Fundus photo taken with a portable handheld camera, FOV: 60 degrees:
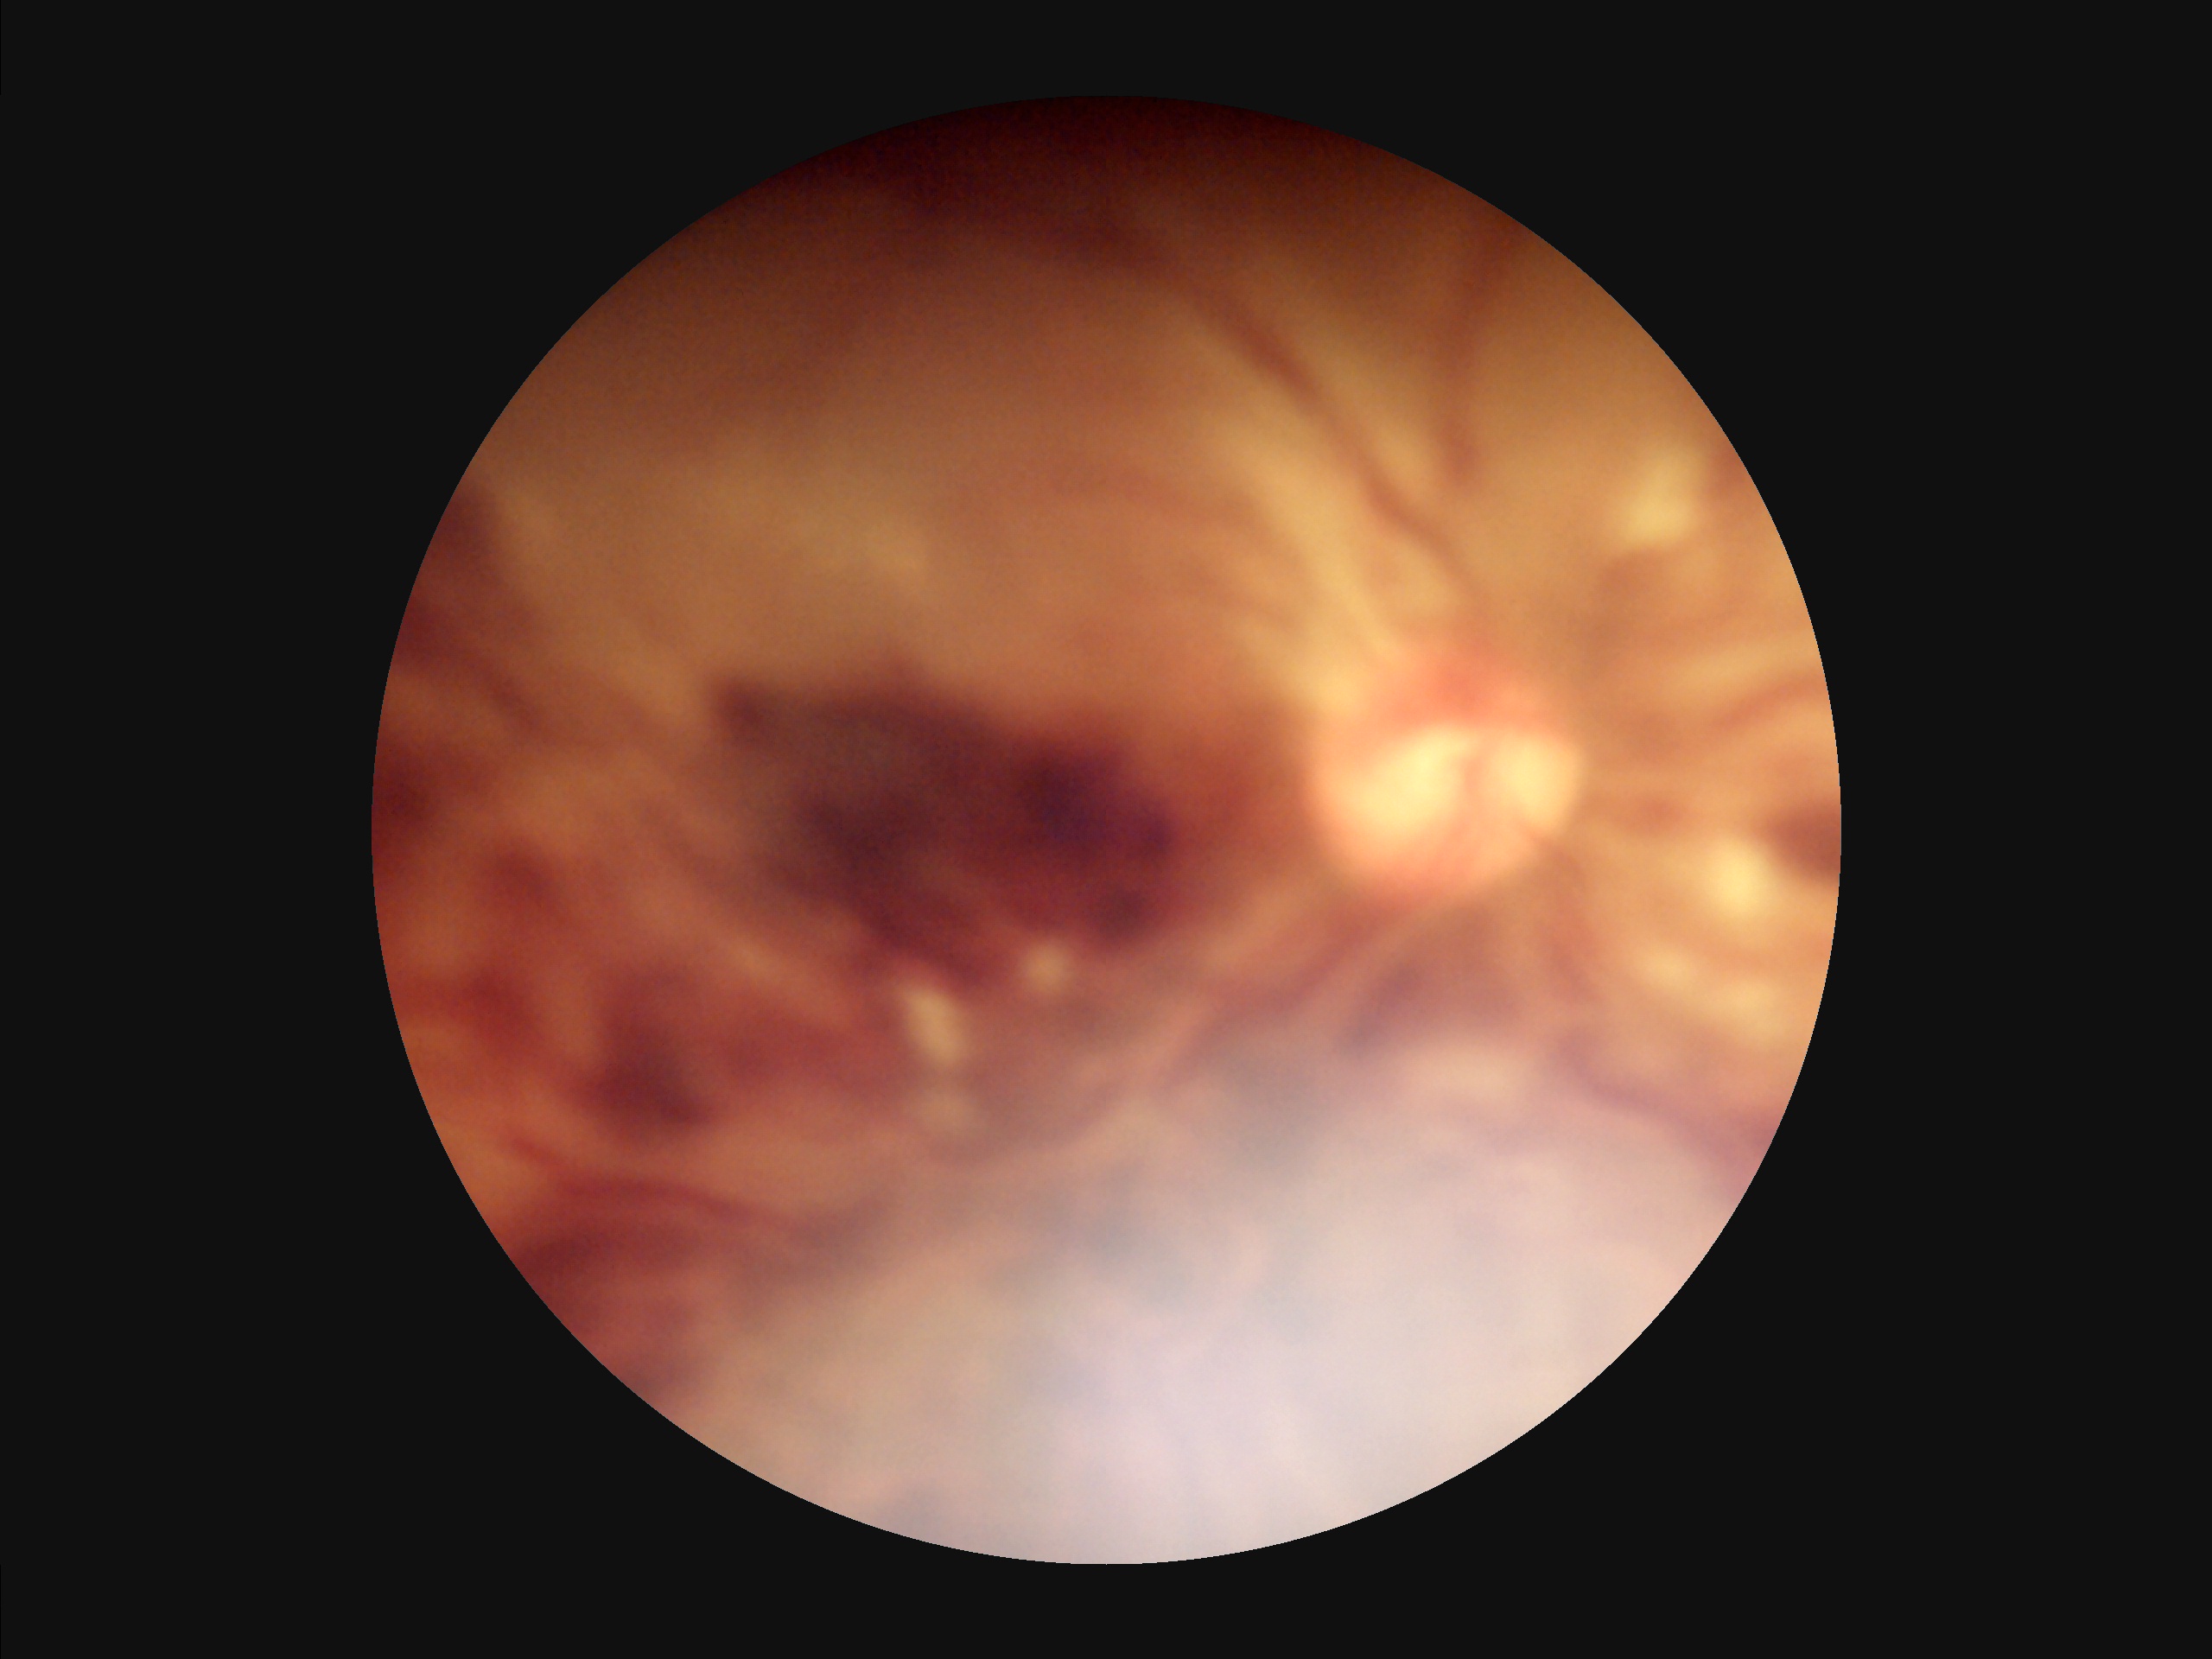

Good dynamic range. Overall quality is poor; the image is difficult to grade. No over- or under-exposure. Noticeable blur in the optic disc, vessels, or background.